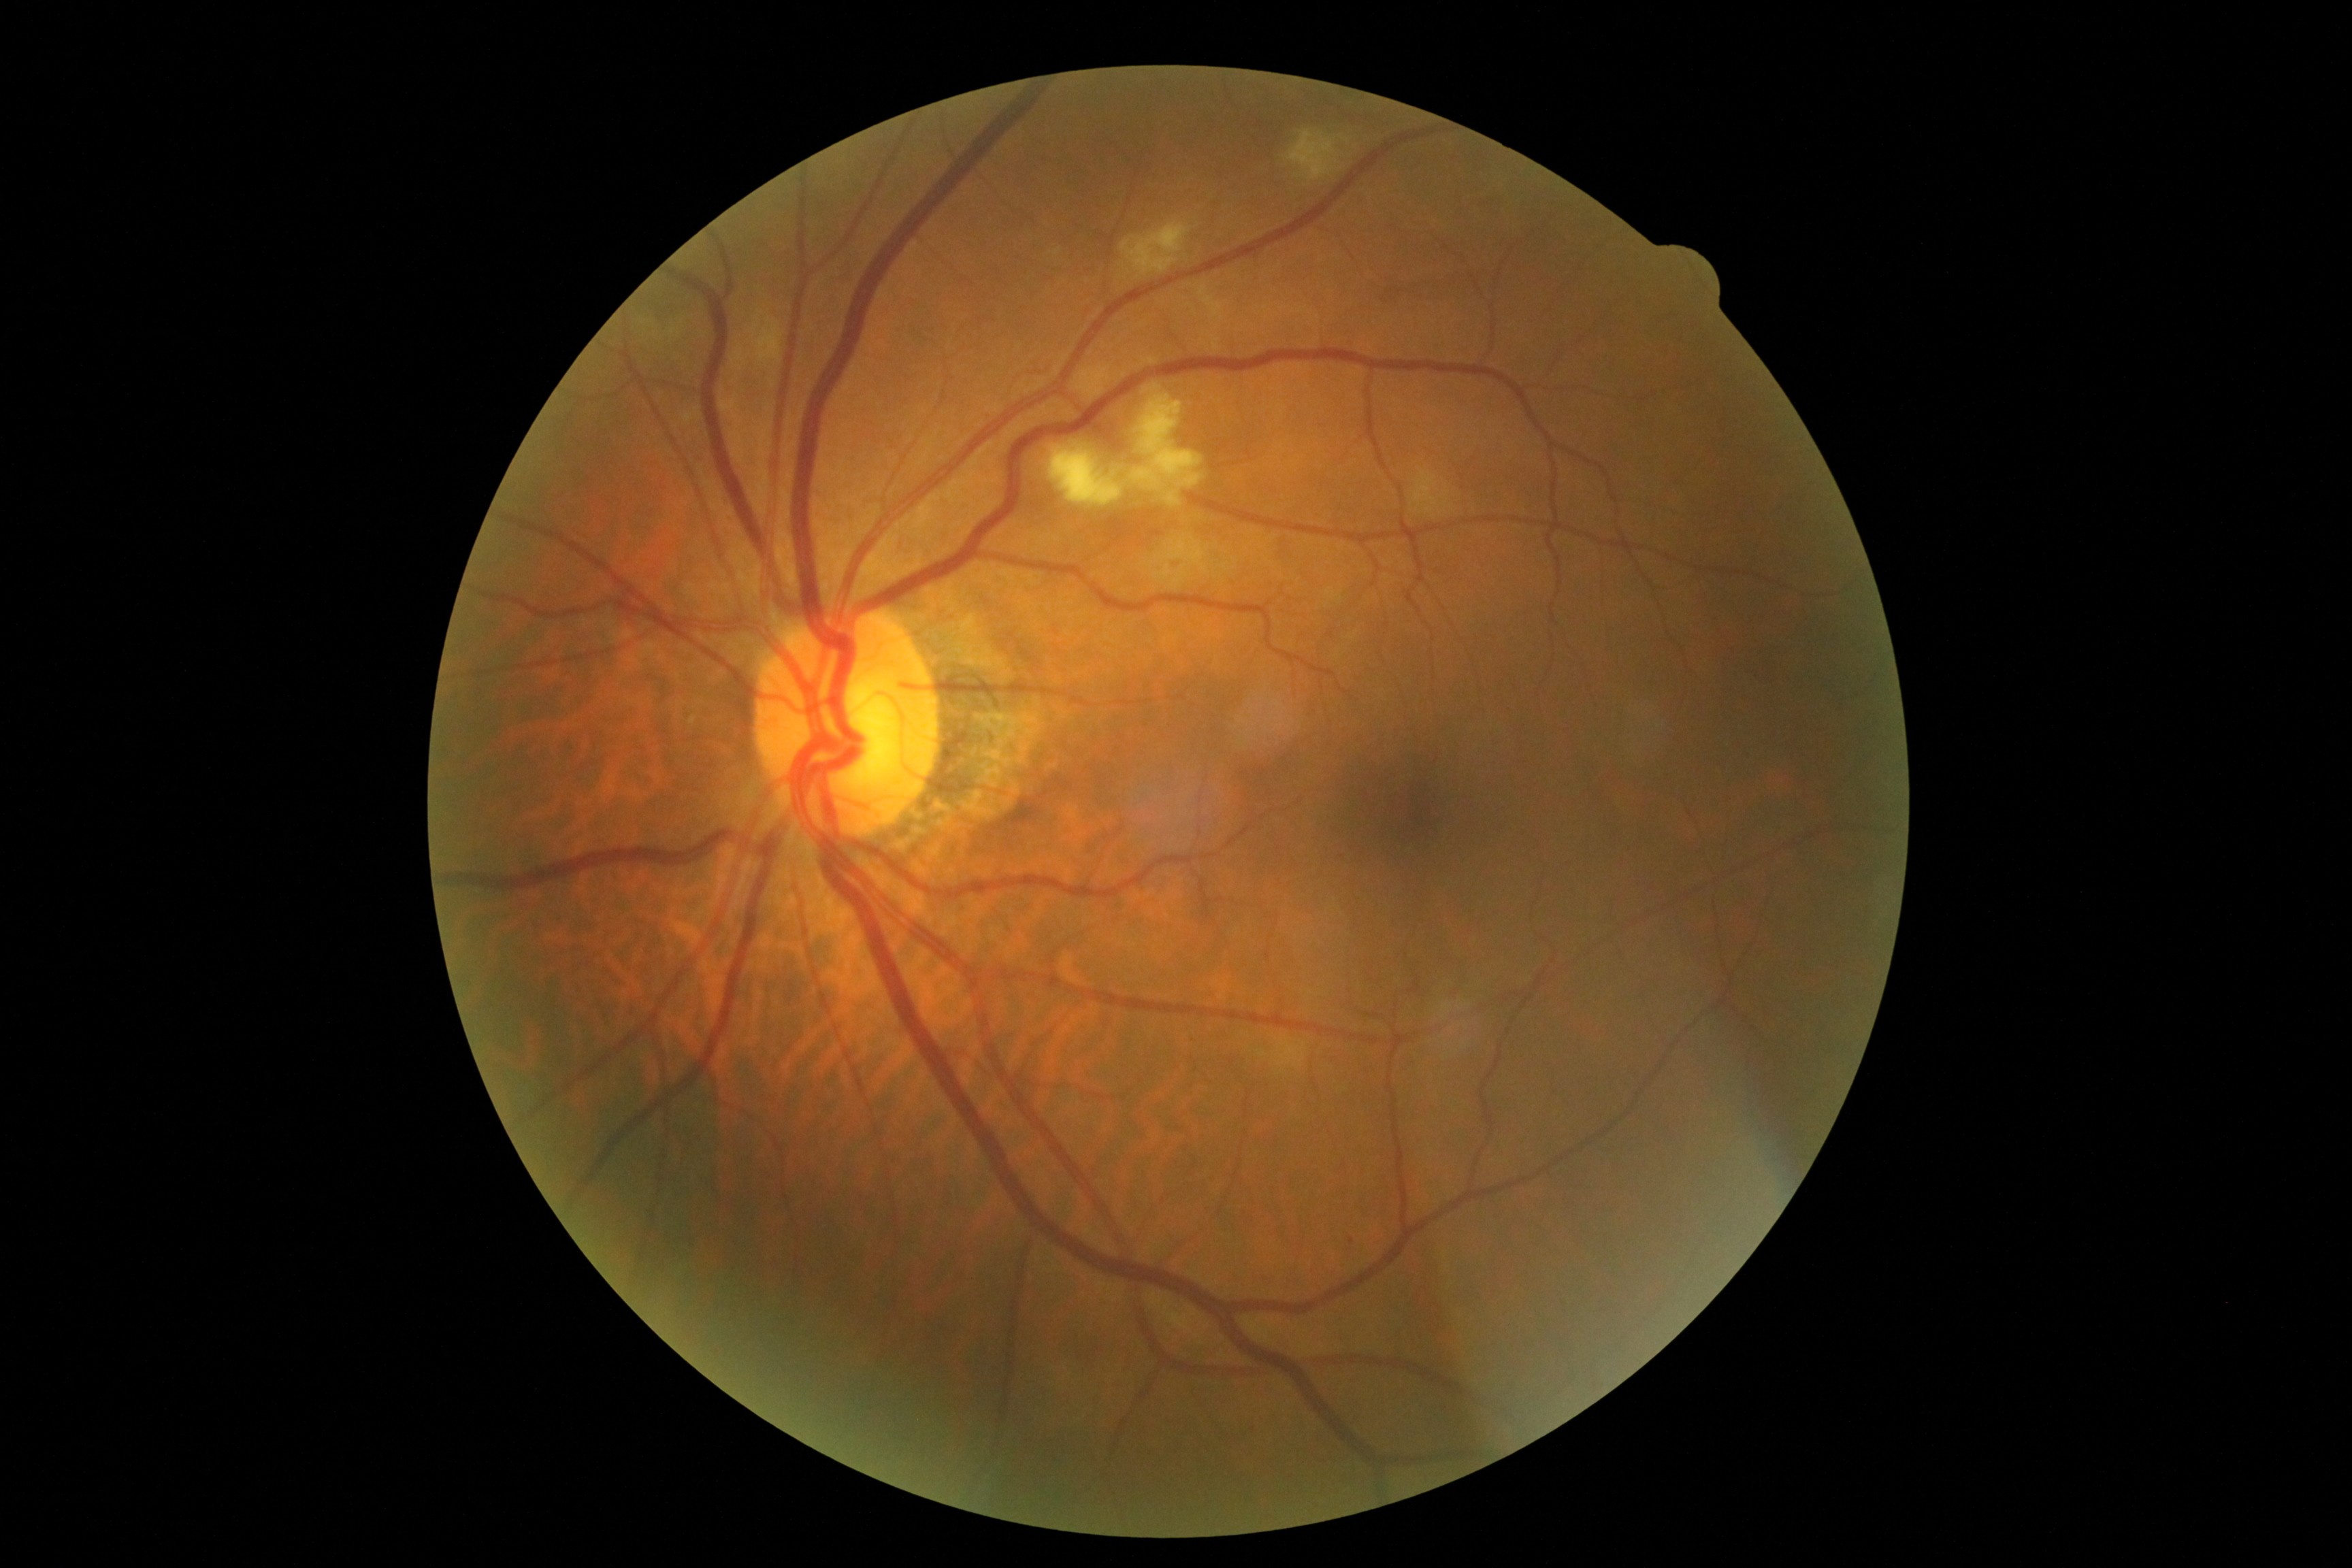

* DR class — non-proliferative diabetic retinopathy
* DR grade — 2